FOV: 45 degrees · nonmydriatic fundus photograph · NIDEK AFC-230 fundus camera — 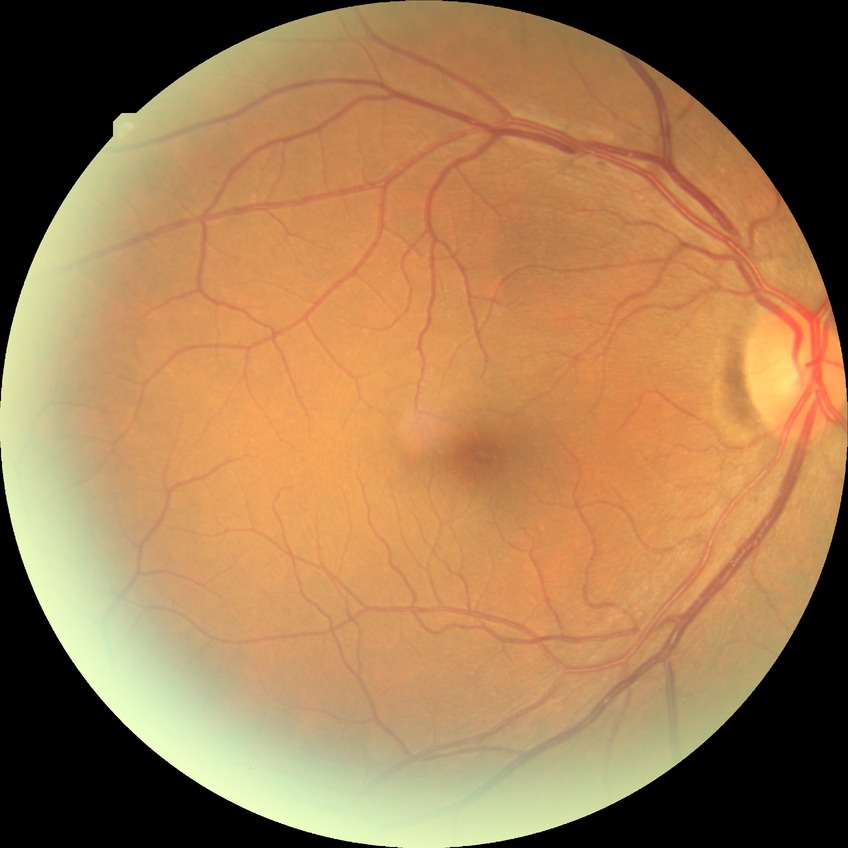
diabetic retinopathy (DR) = NDR (no diabetic retinopathy).